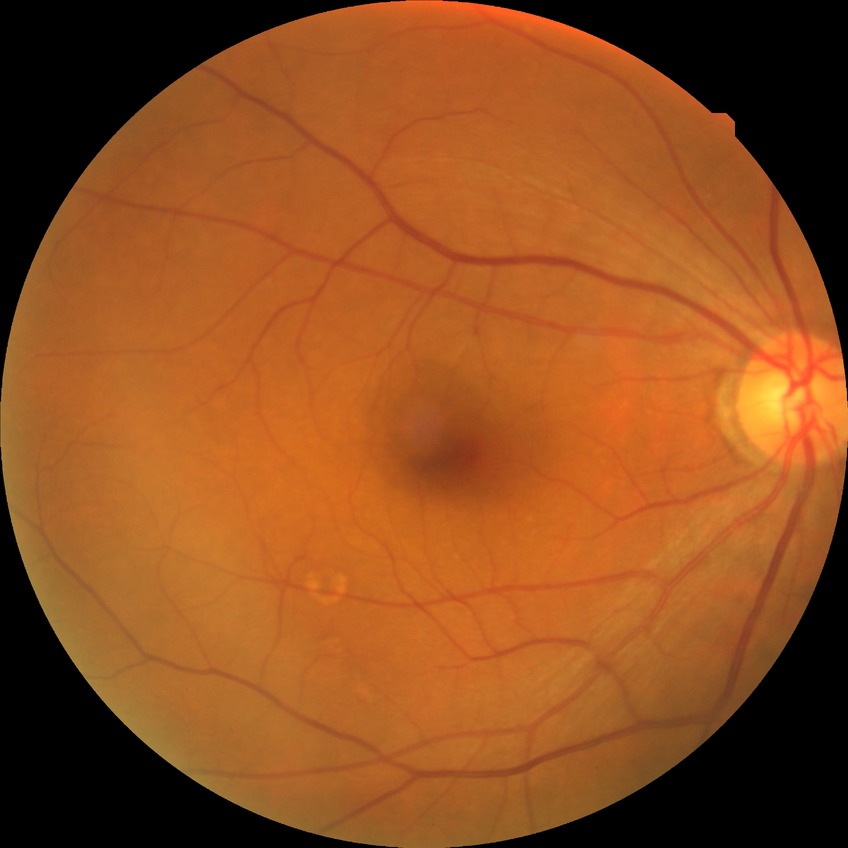

Diabetic retinopathy (DR): no diabetic retinopathy (NDR).